FOV: 45 degrees
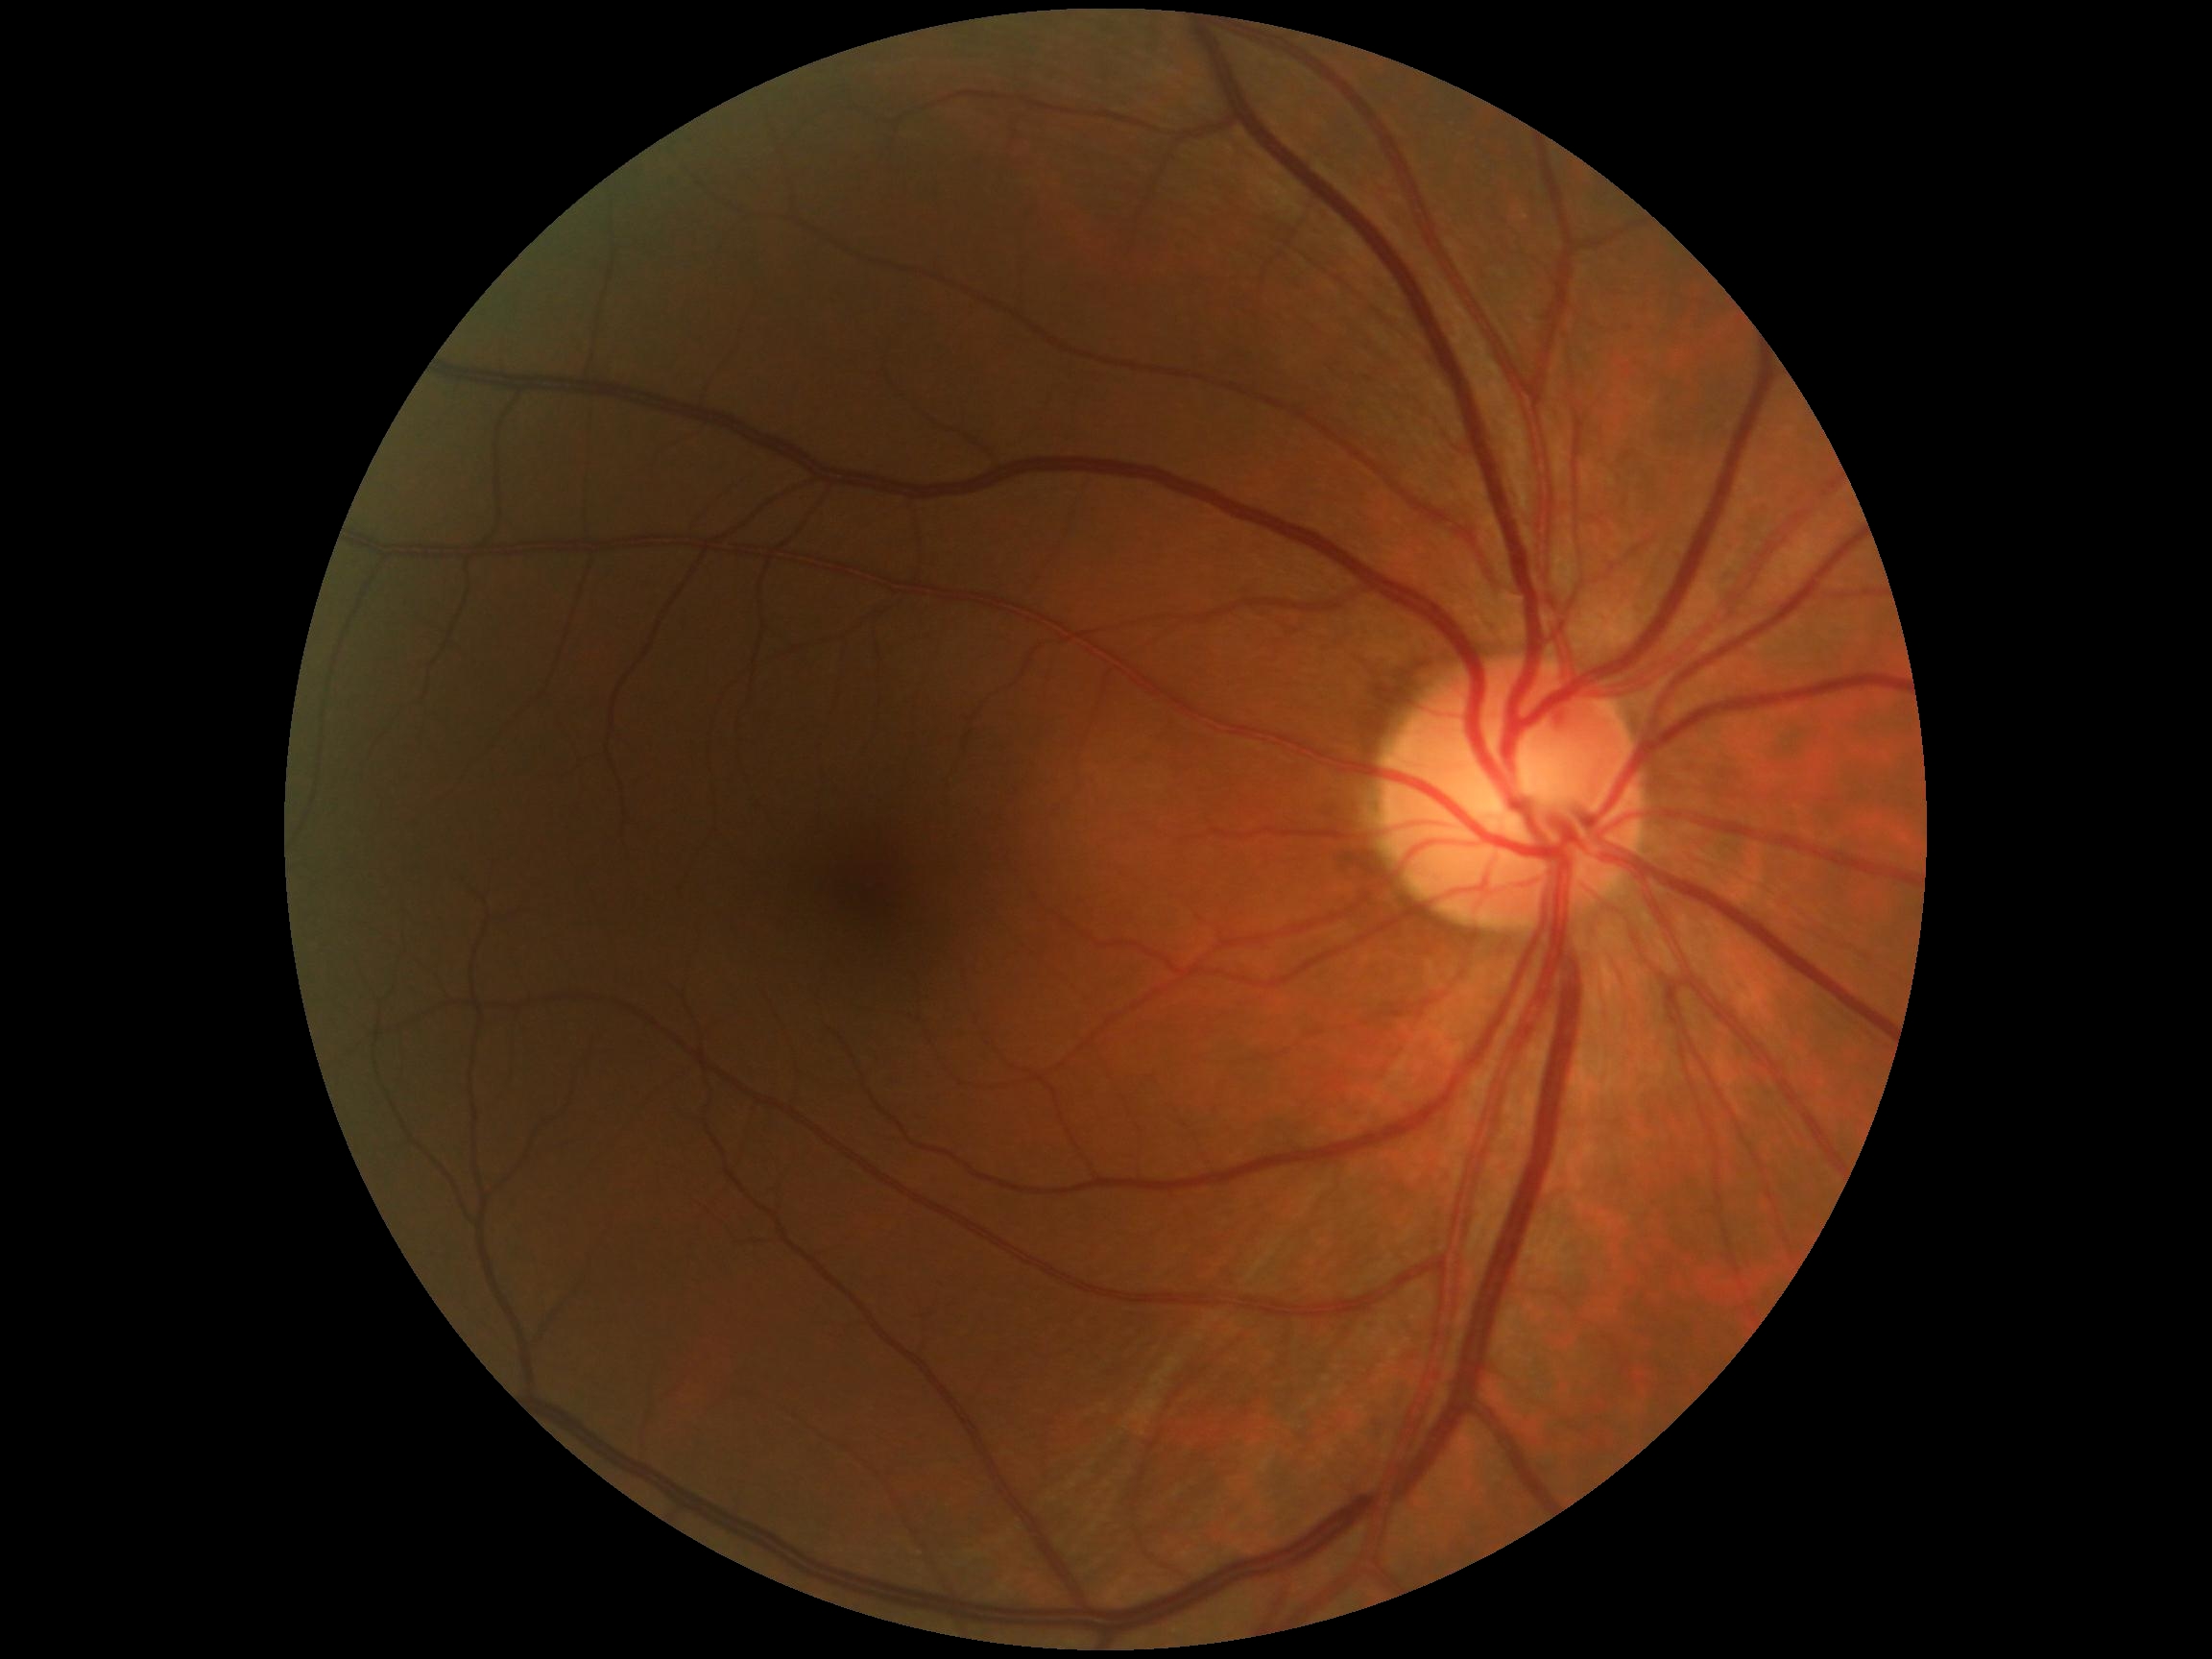
dr_grade: 0/4